1960x1897px, FOV: 45 degrees, color fundus image:
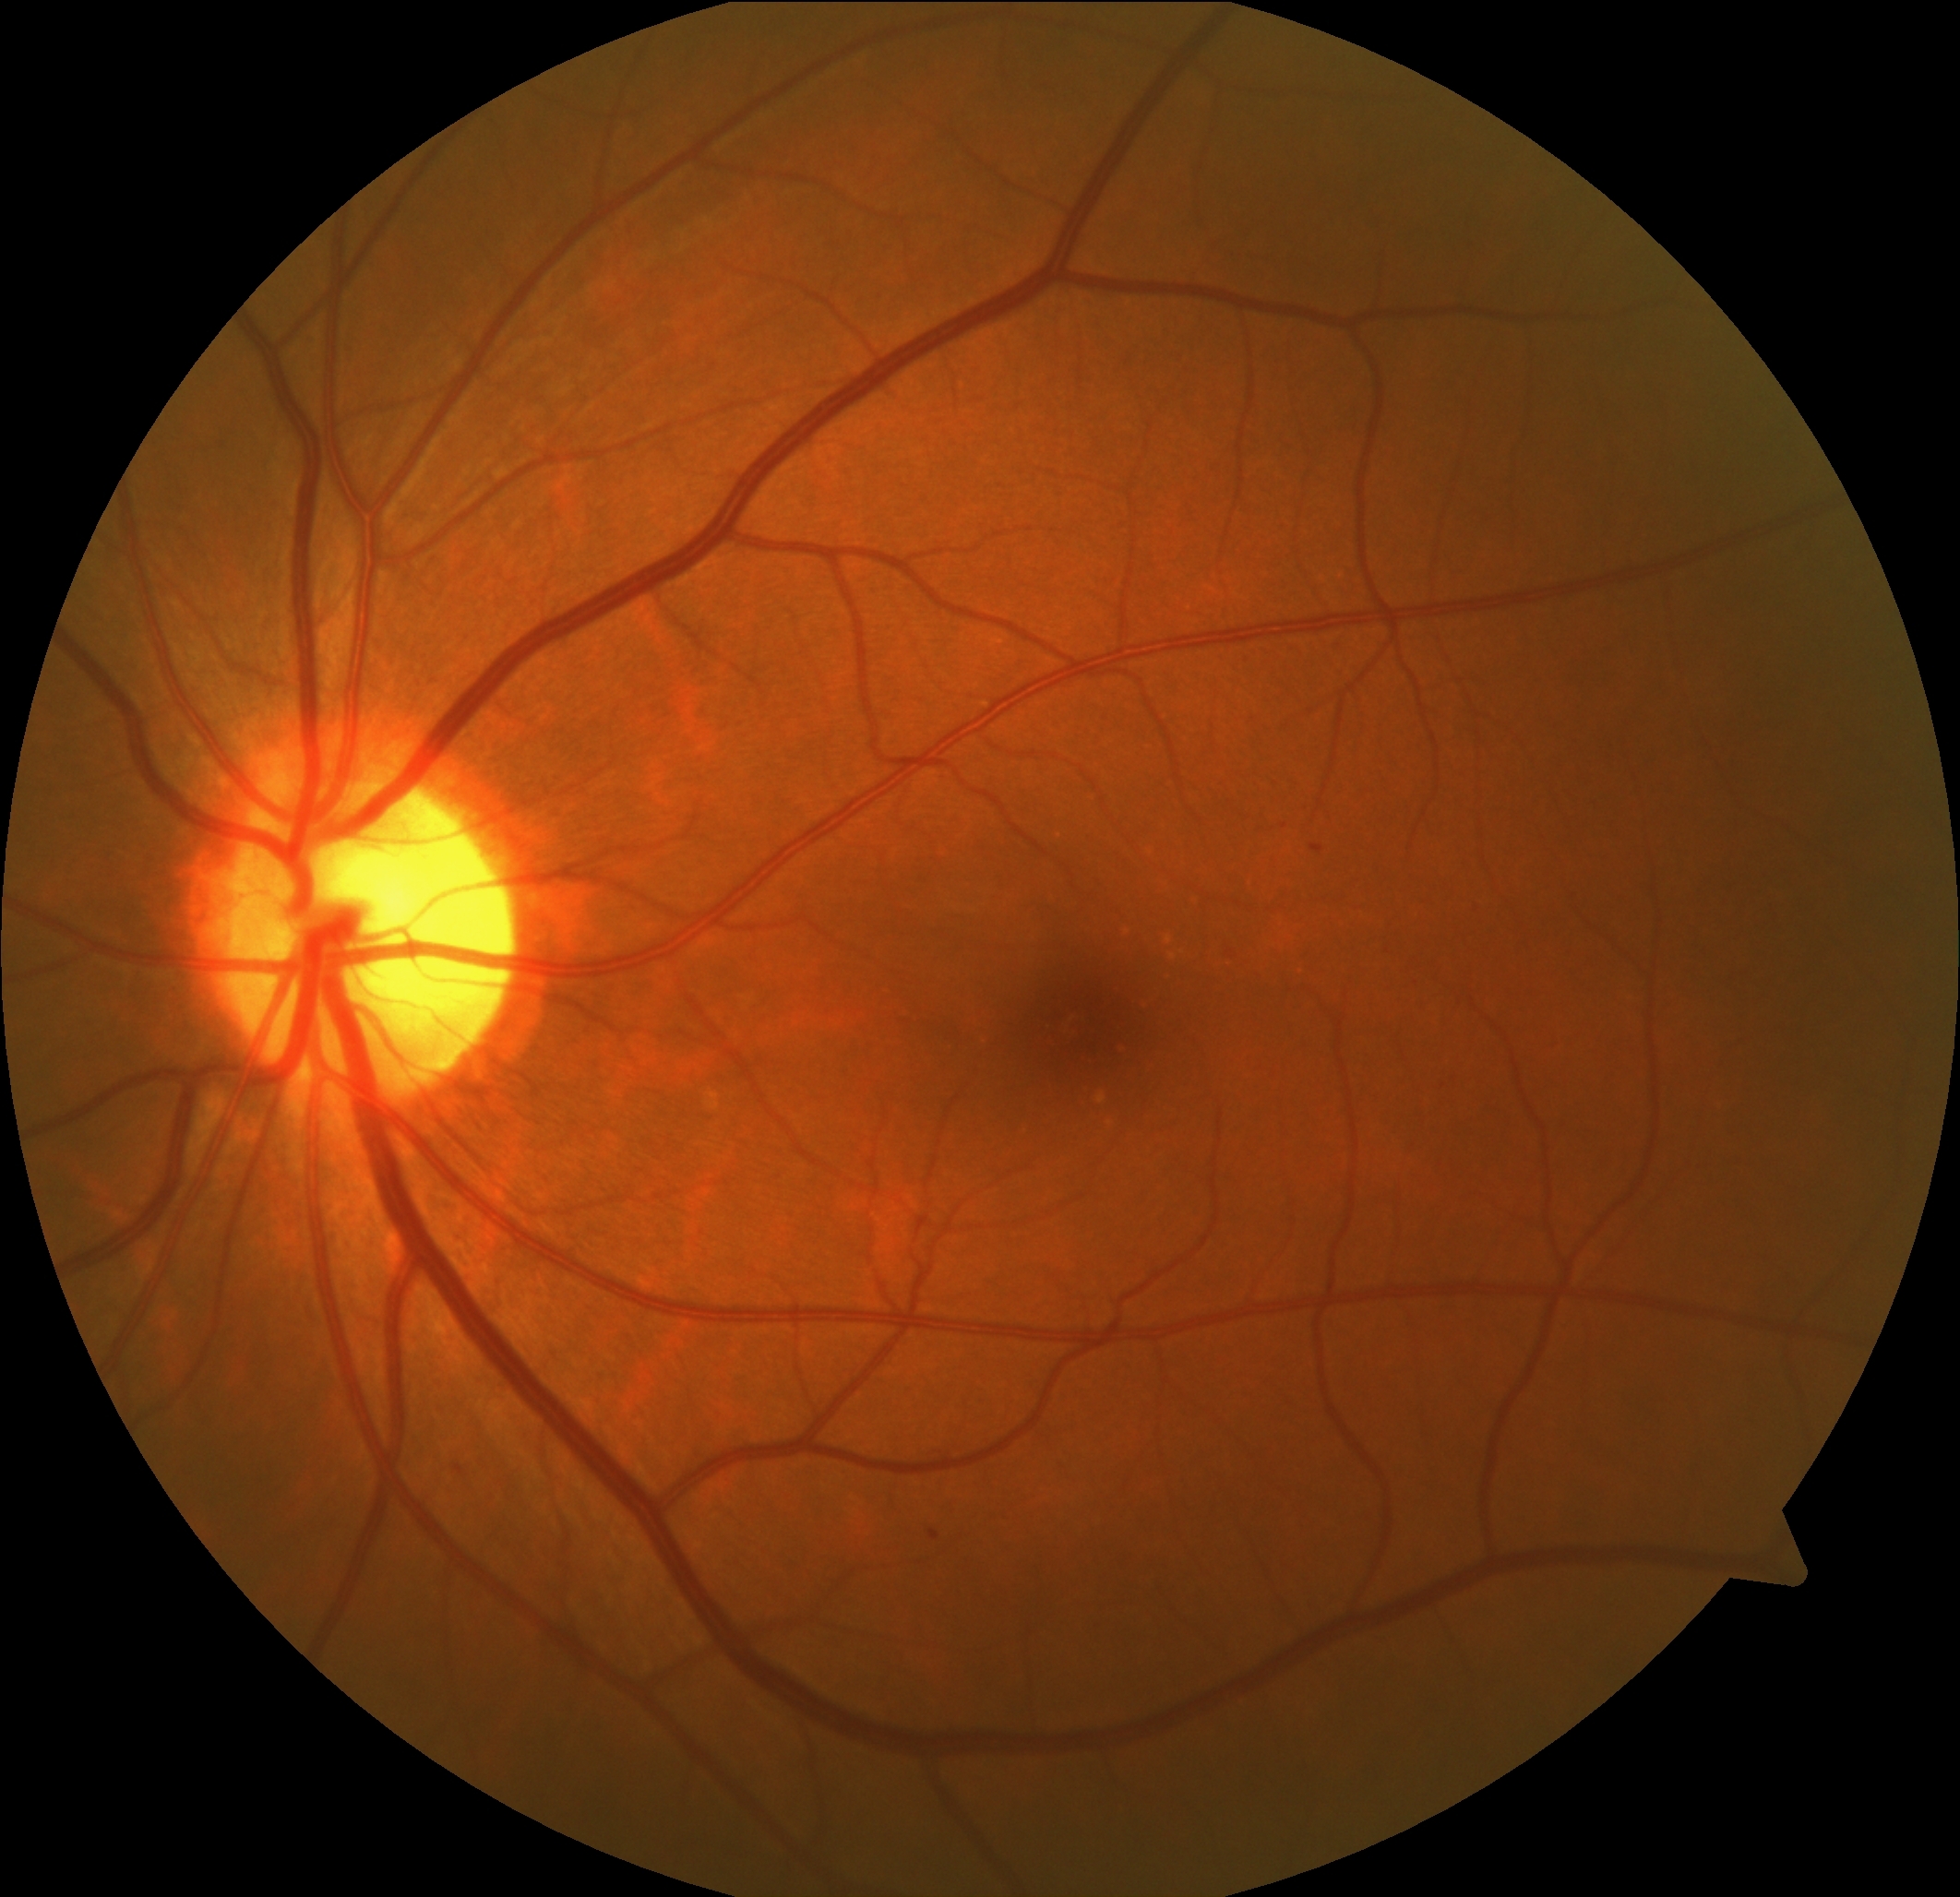

Diabetic retinopathy (DR): grade 1 (mild NPDR).